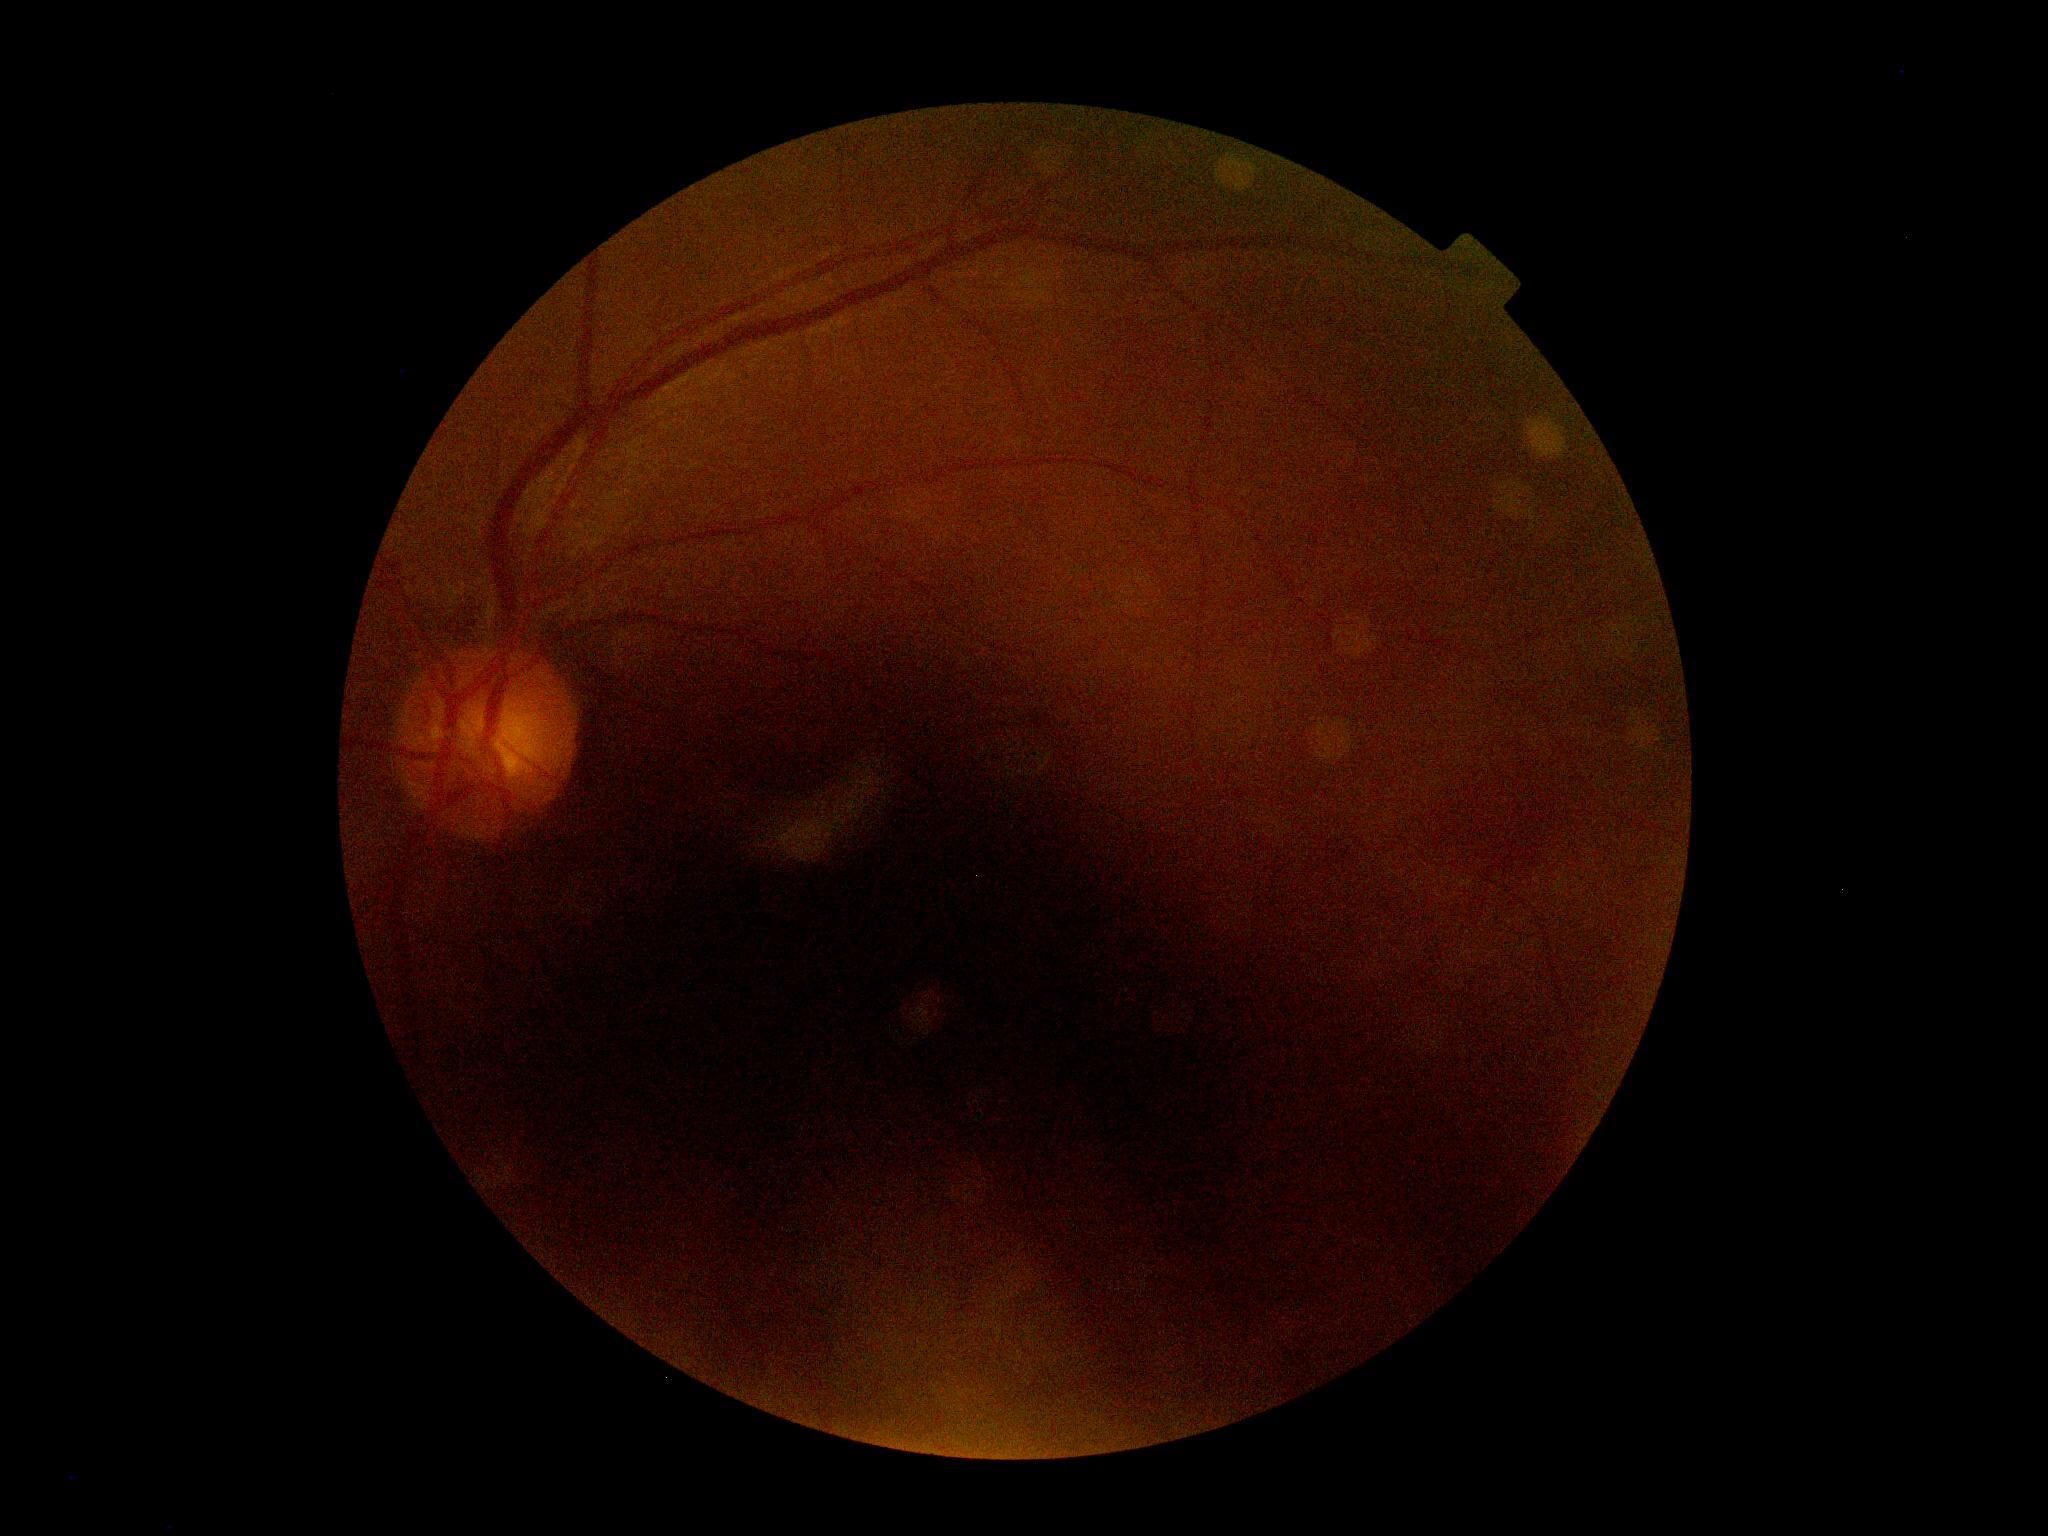

  quality: below grading threshold
  dr_grade: ungradable due to poor image quality